45-degree field of view — 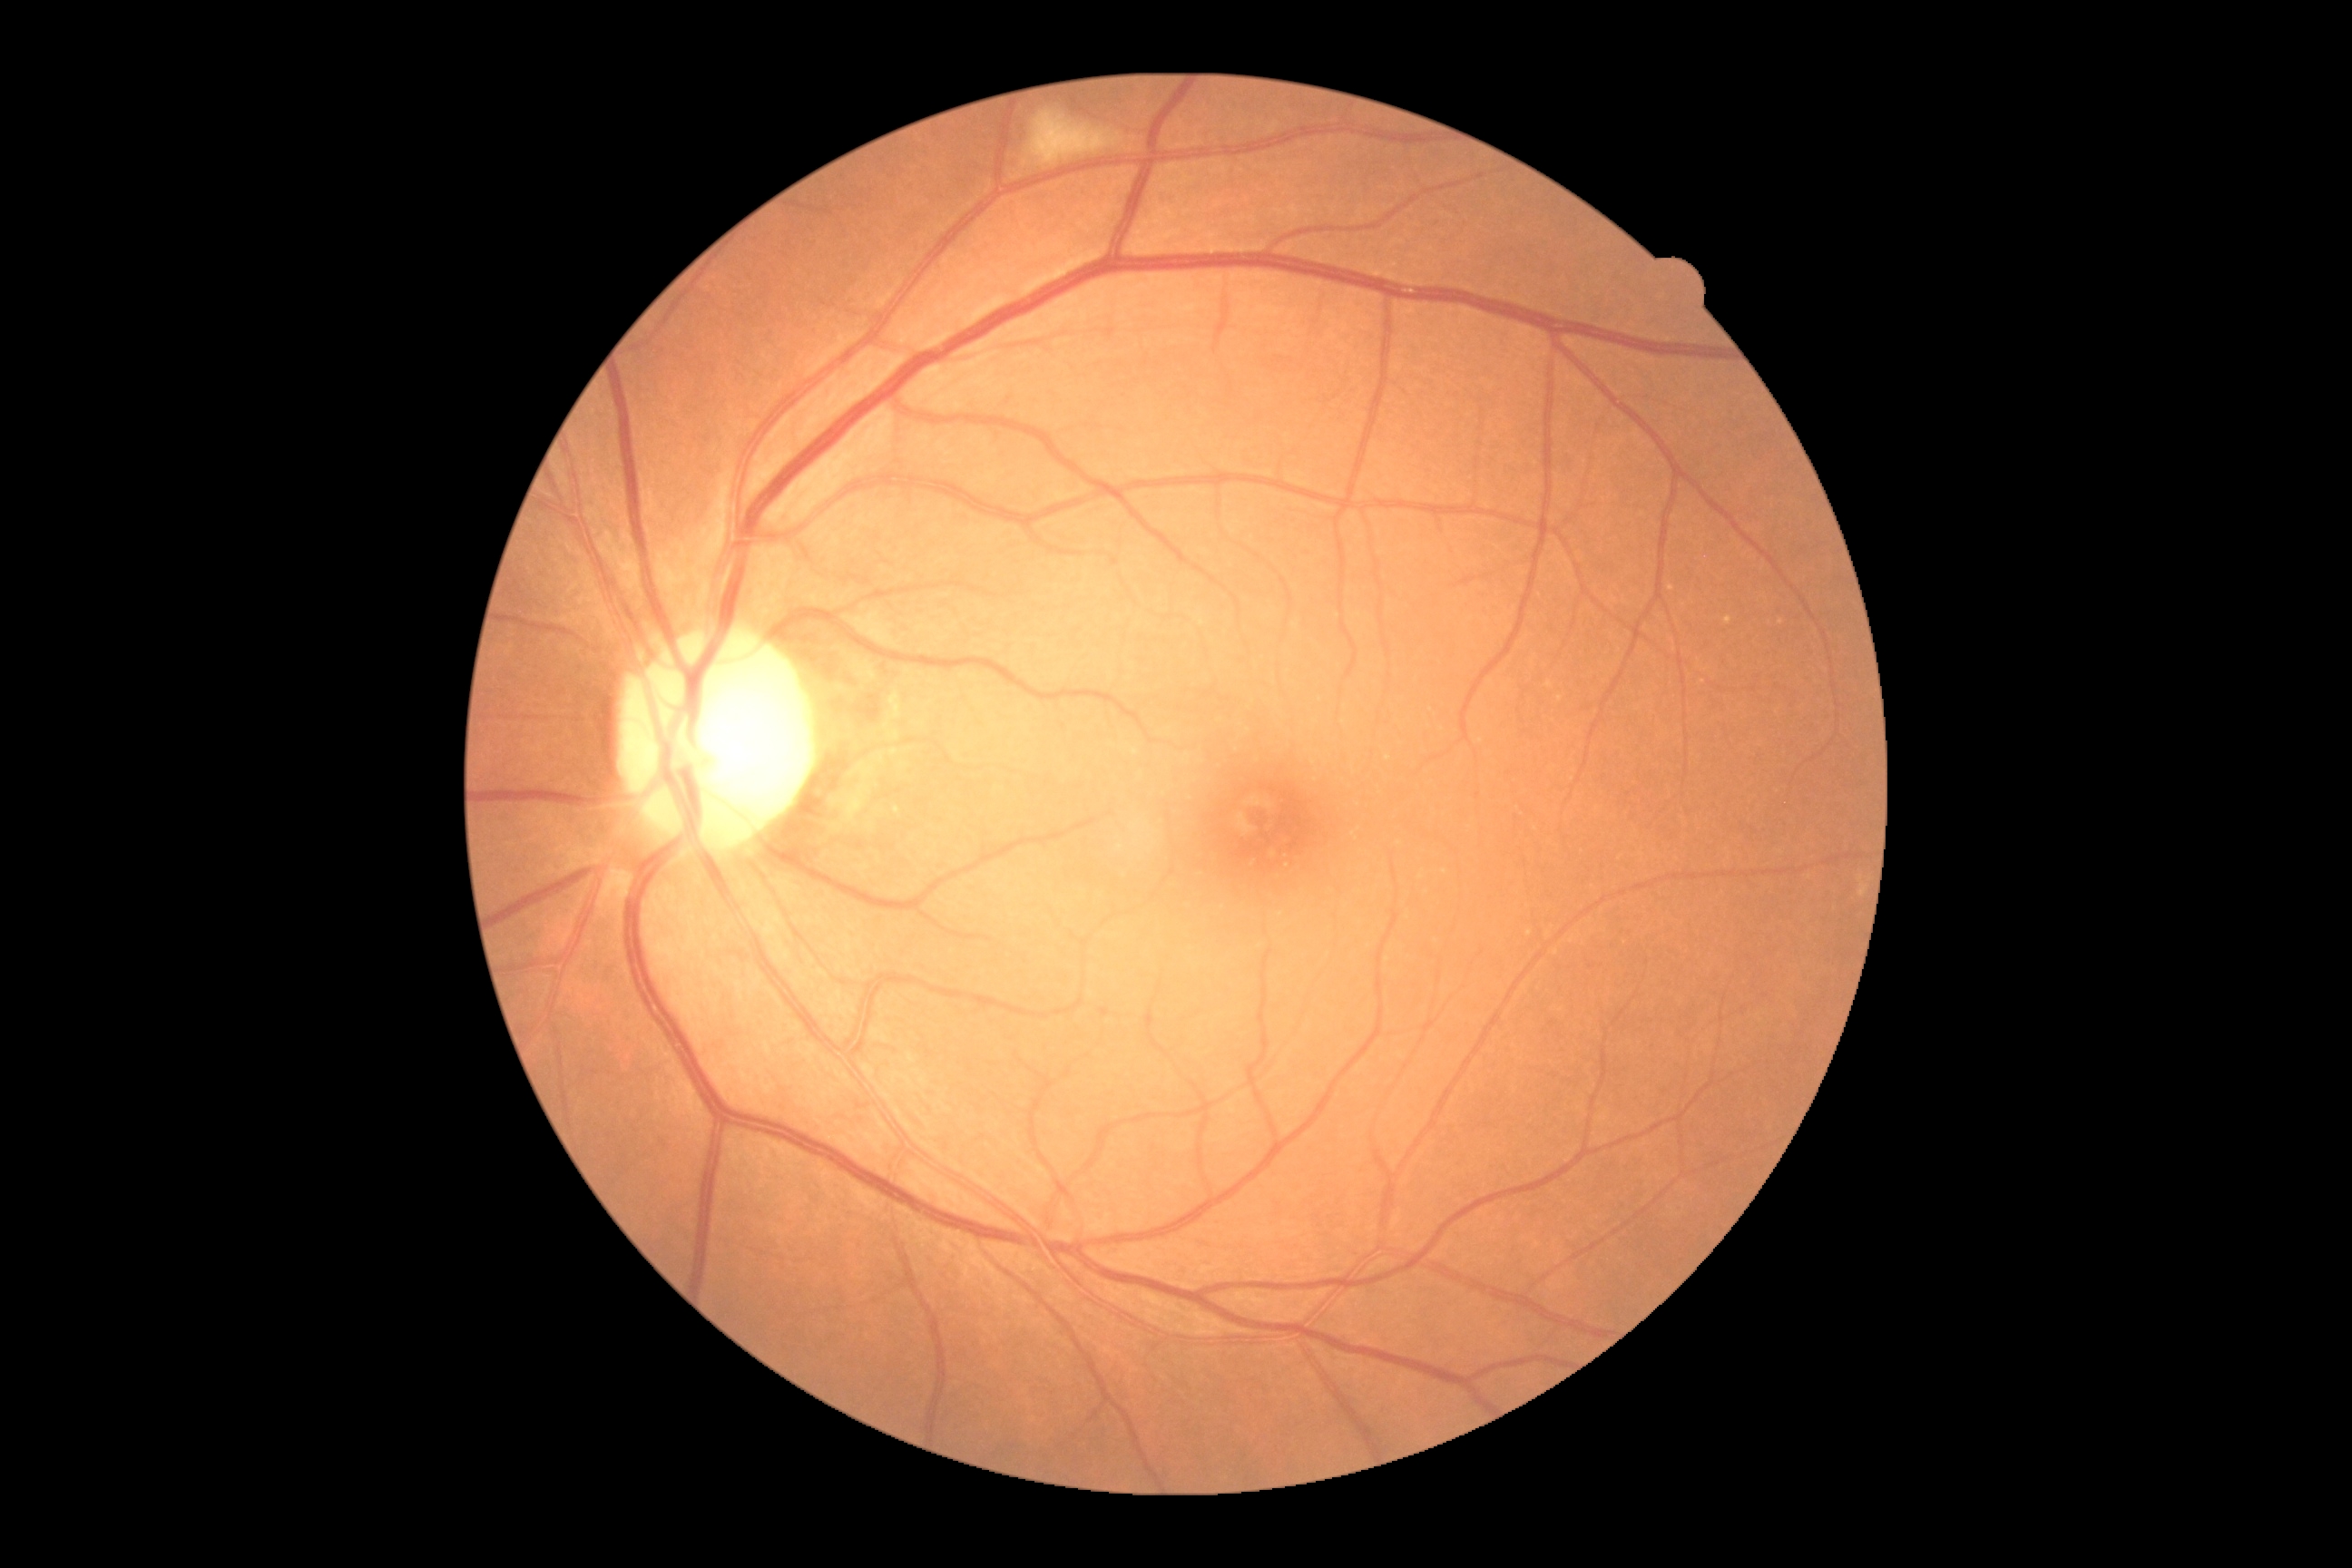 DR class=non-proliferative diabetic retinopathy, DR stage=2.